Acquired with a NIDEK AFC-230, DR severity per modified Davis staging
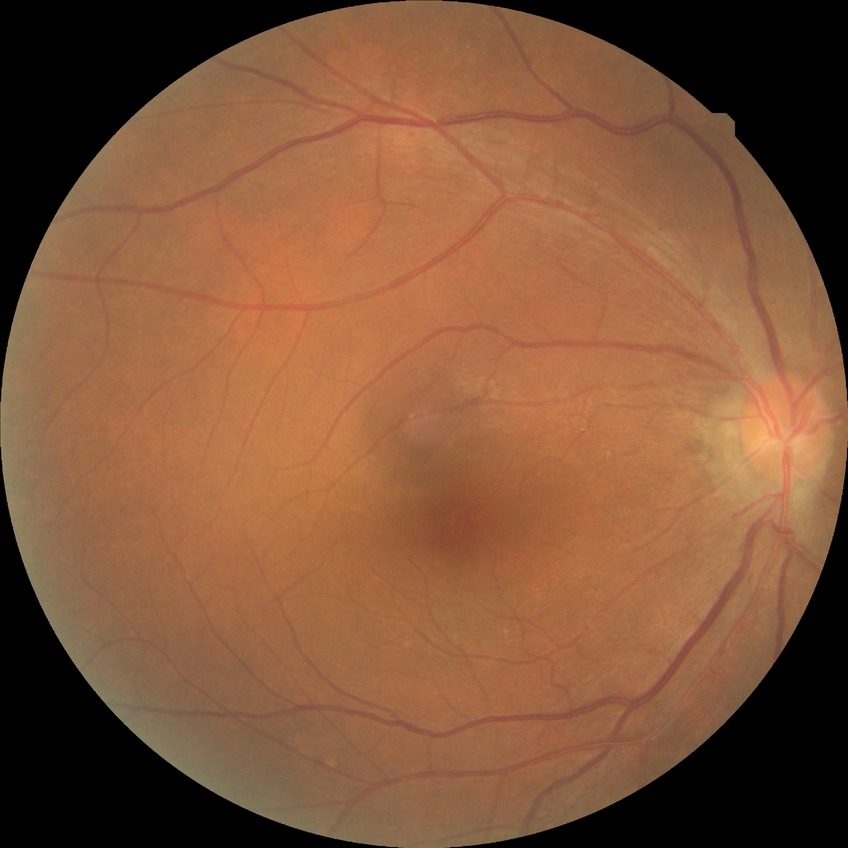

Annotations:
• diabetic retinopathy (DR) — no diabetic retinopathy (NDR)